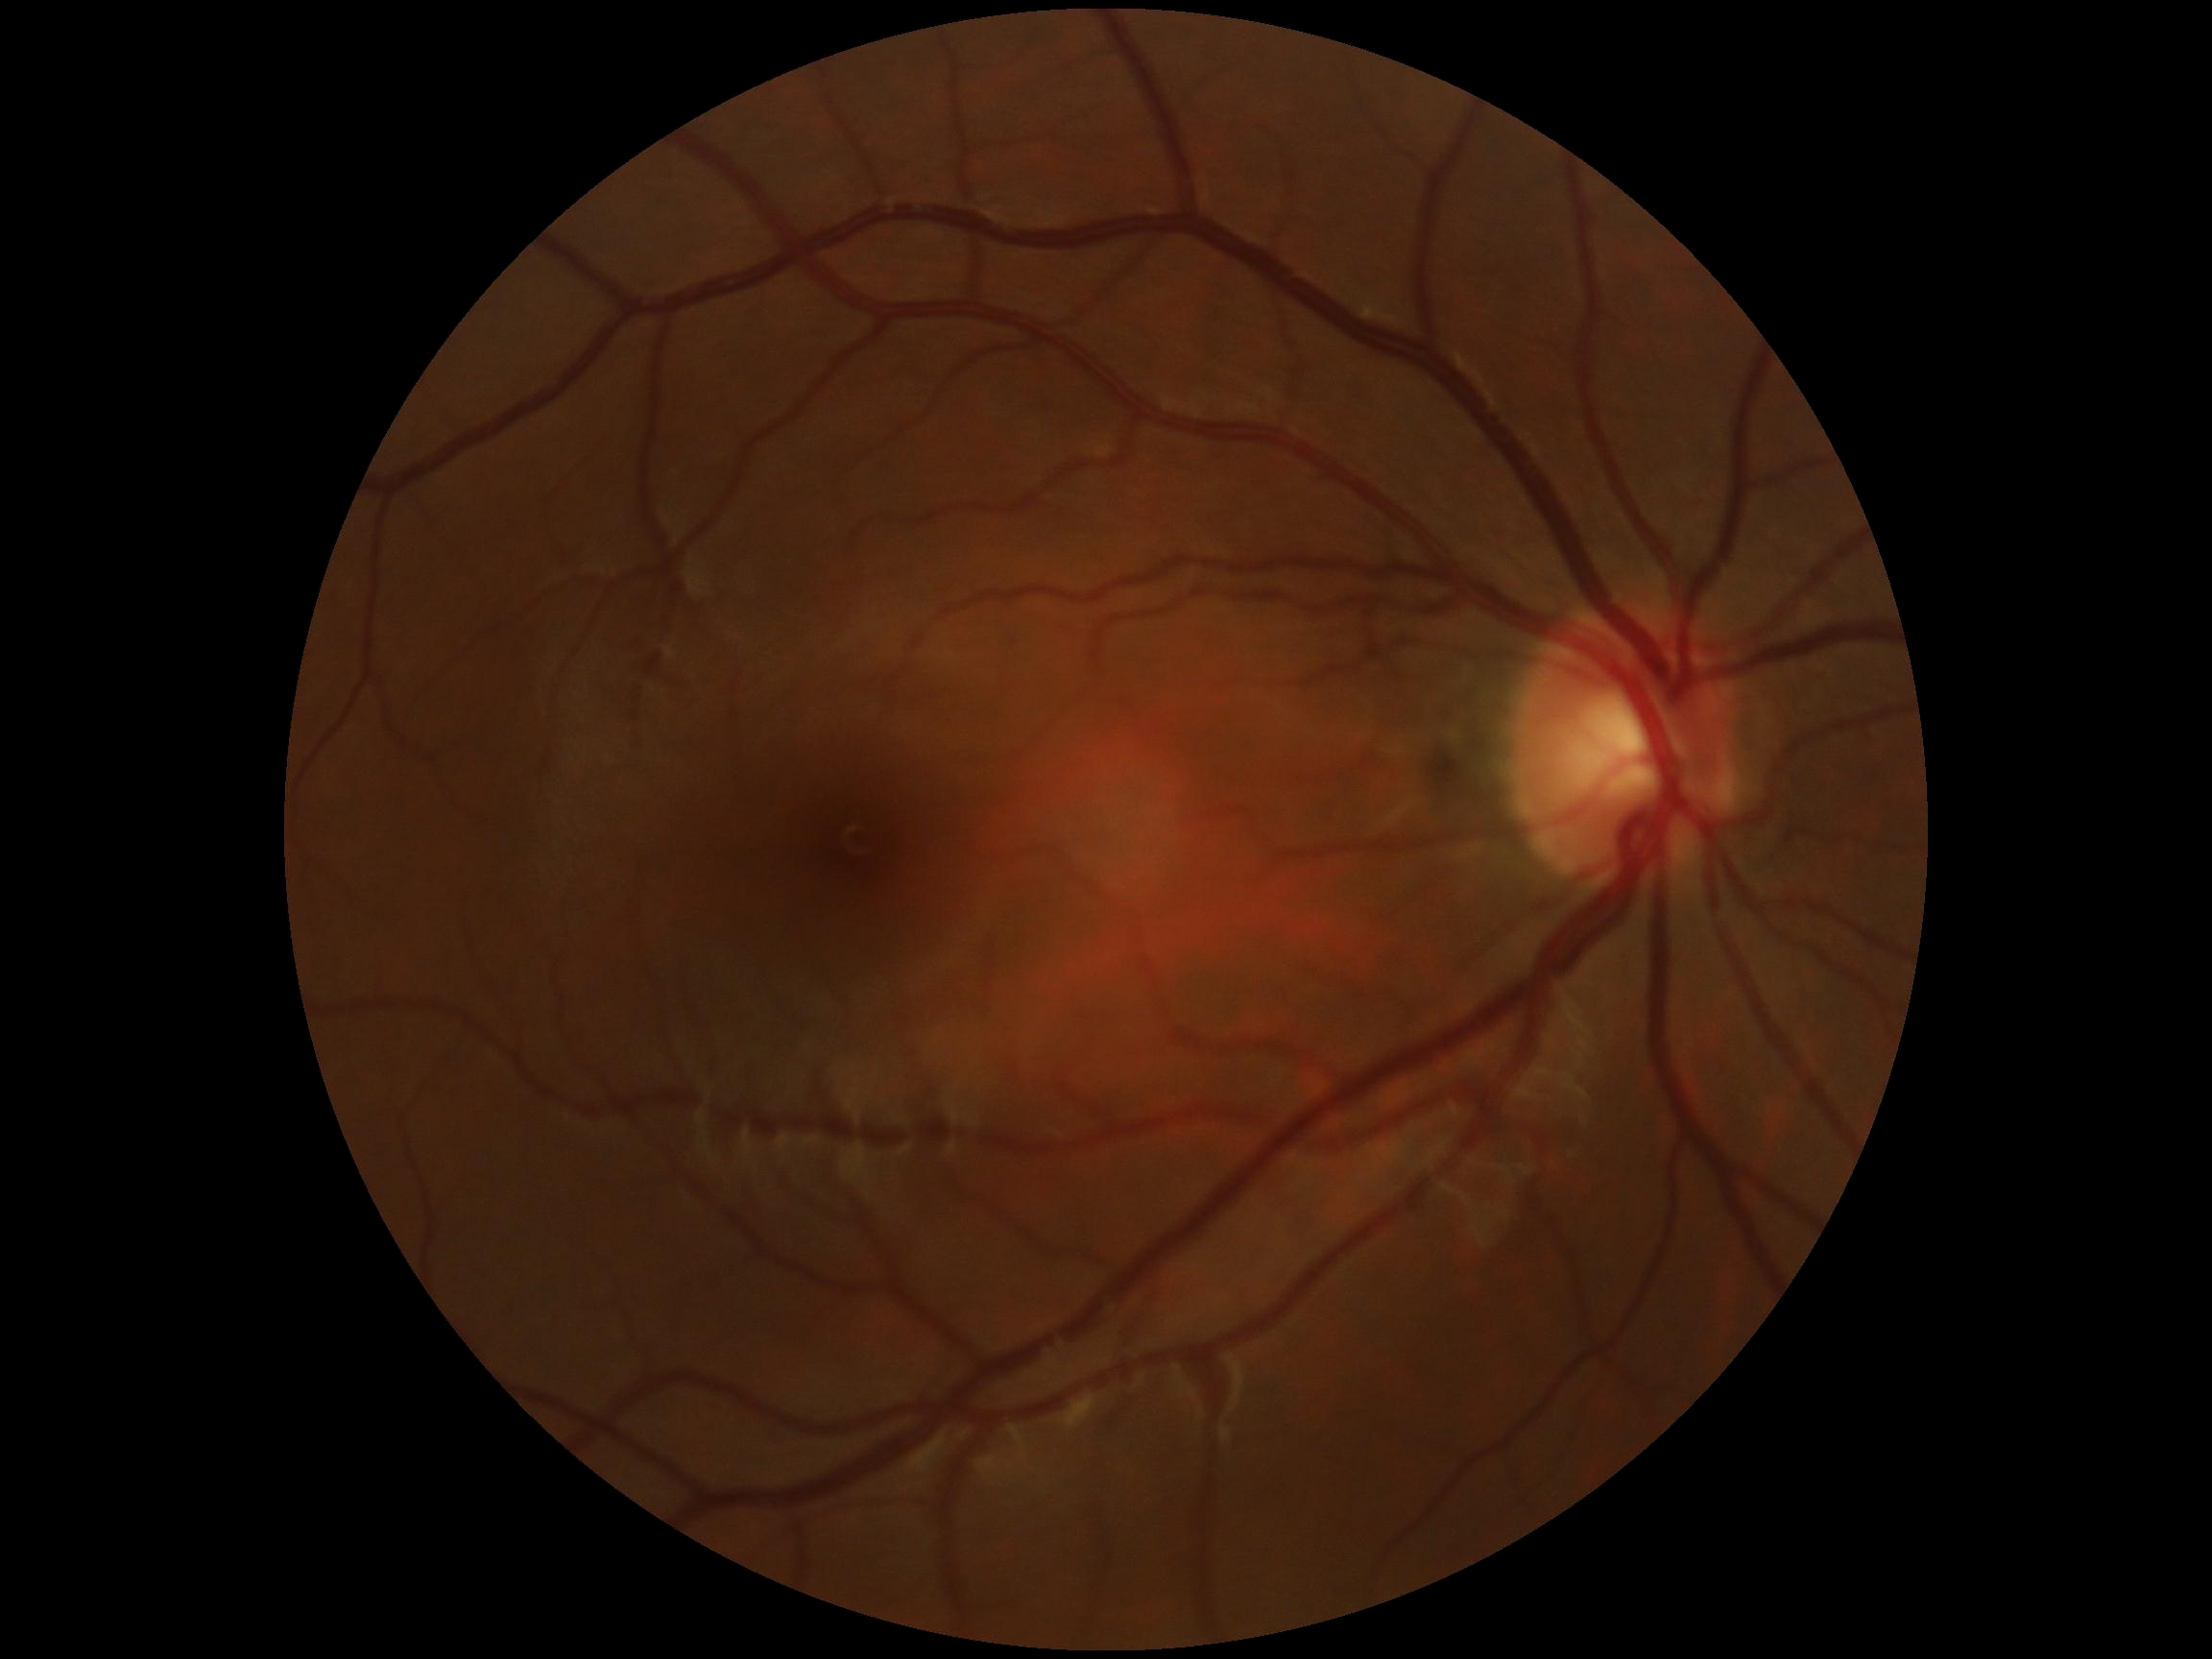

DR: grade 0 (no apparent retinopathy).